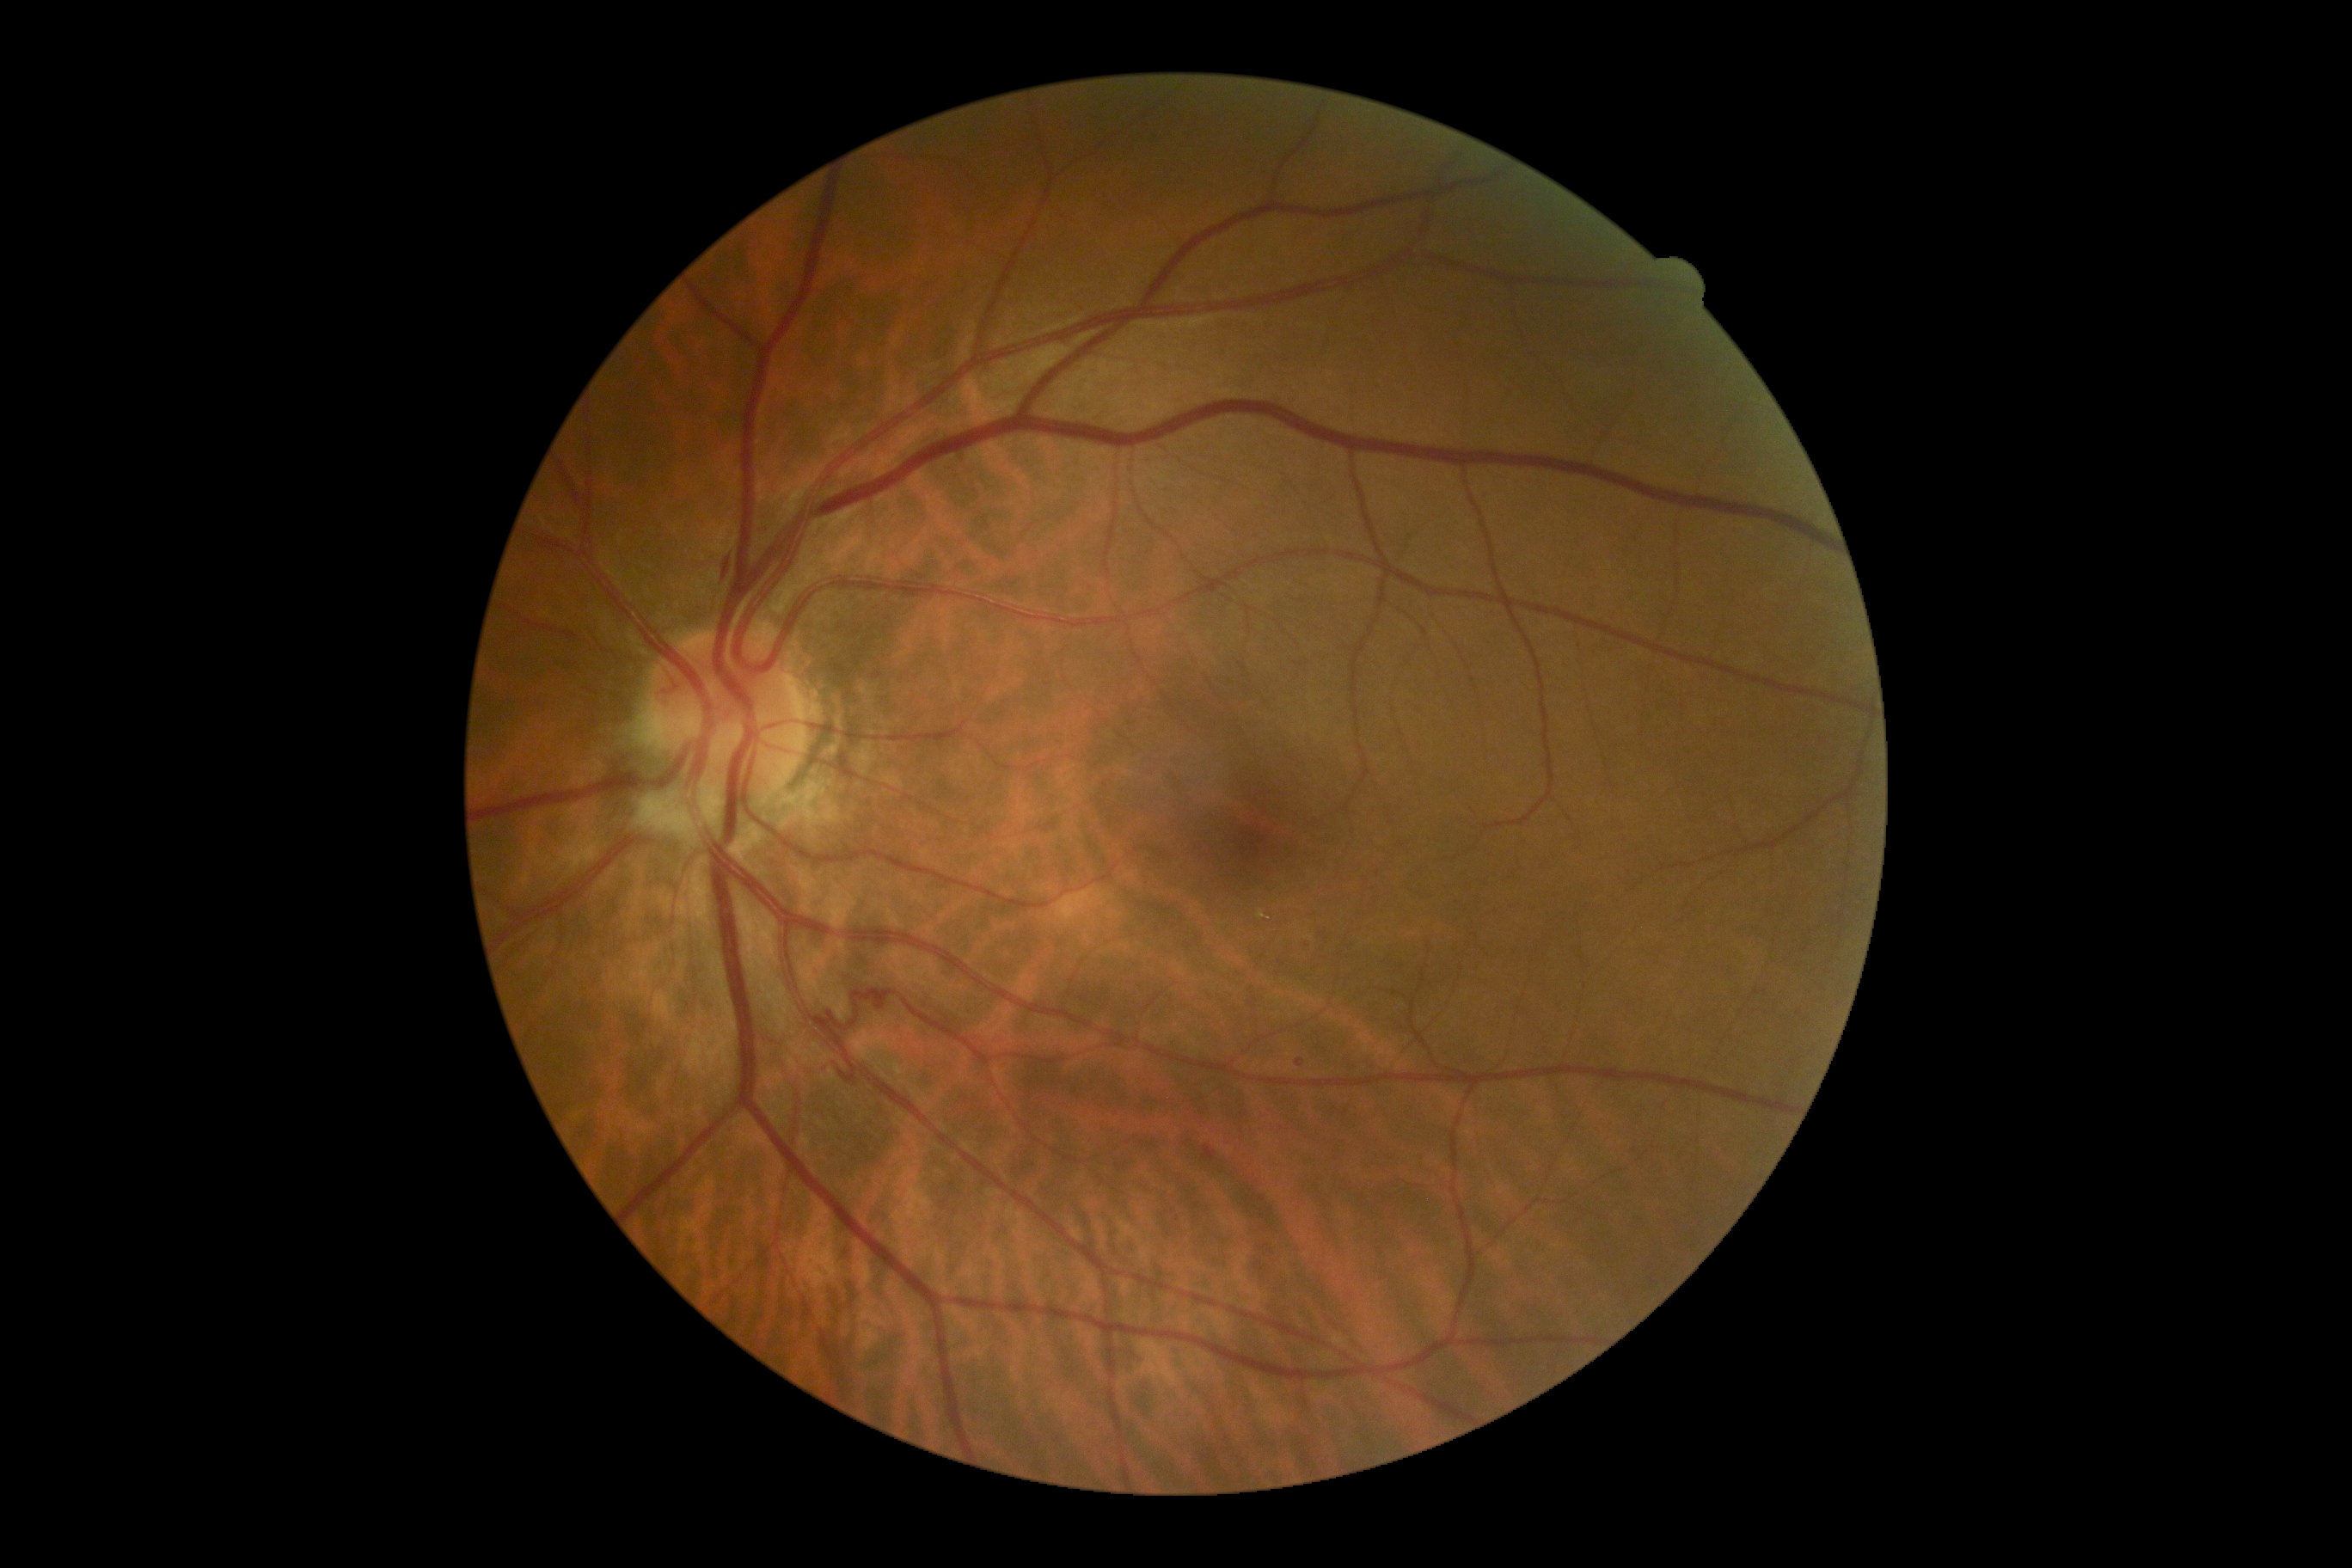
DR: 2.